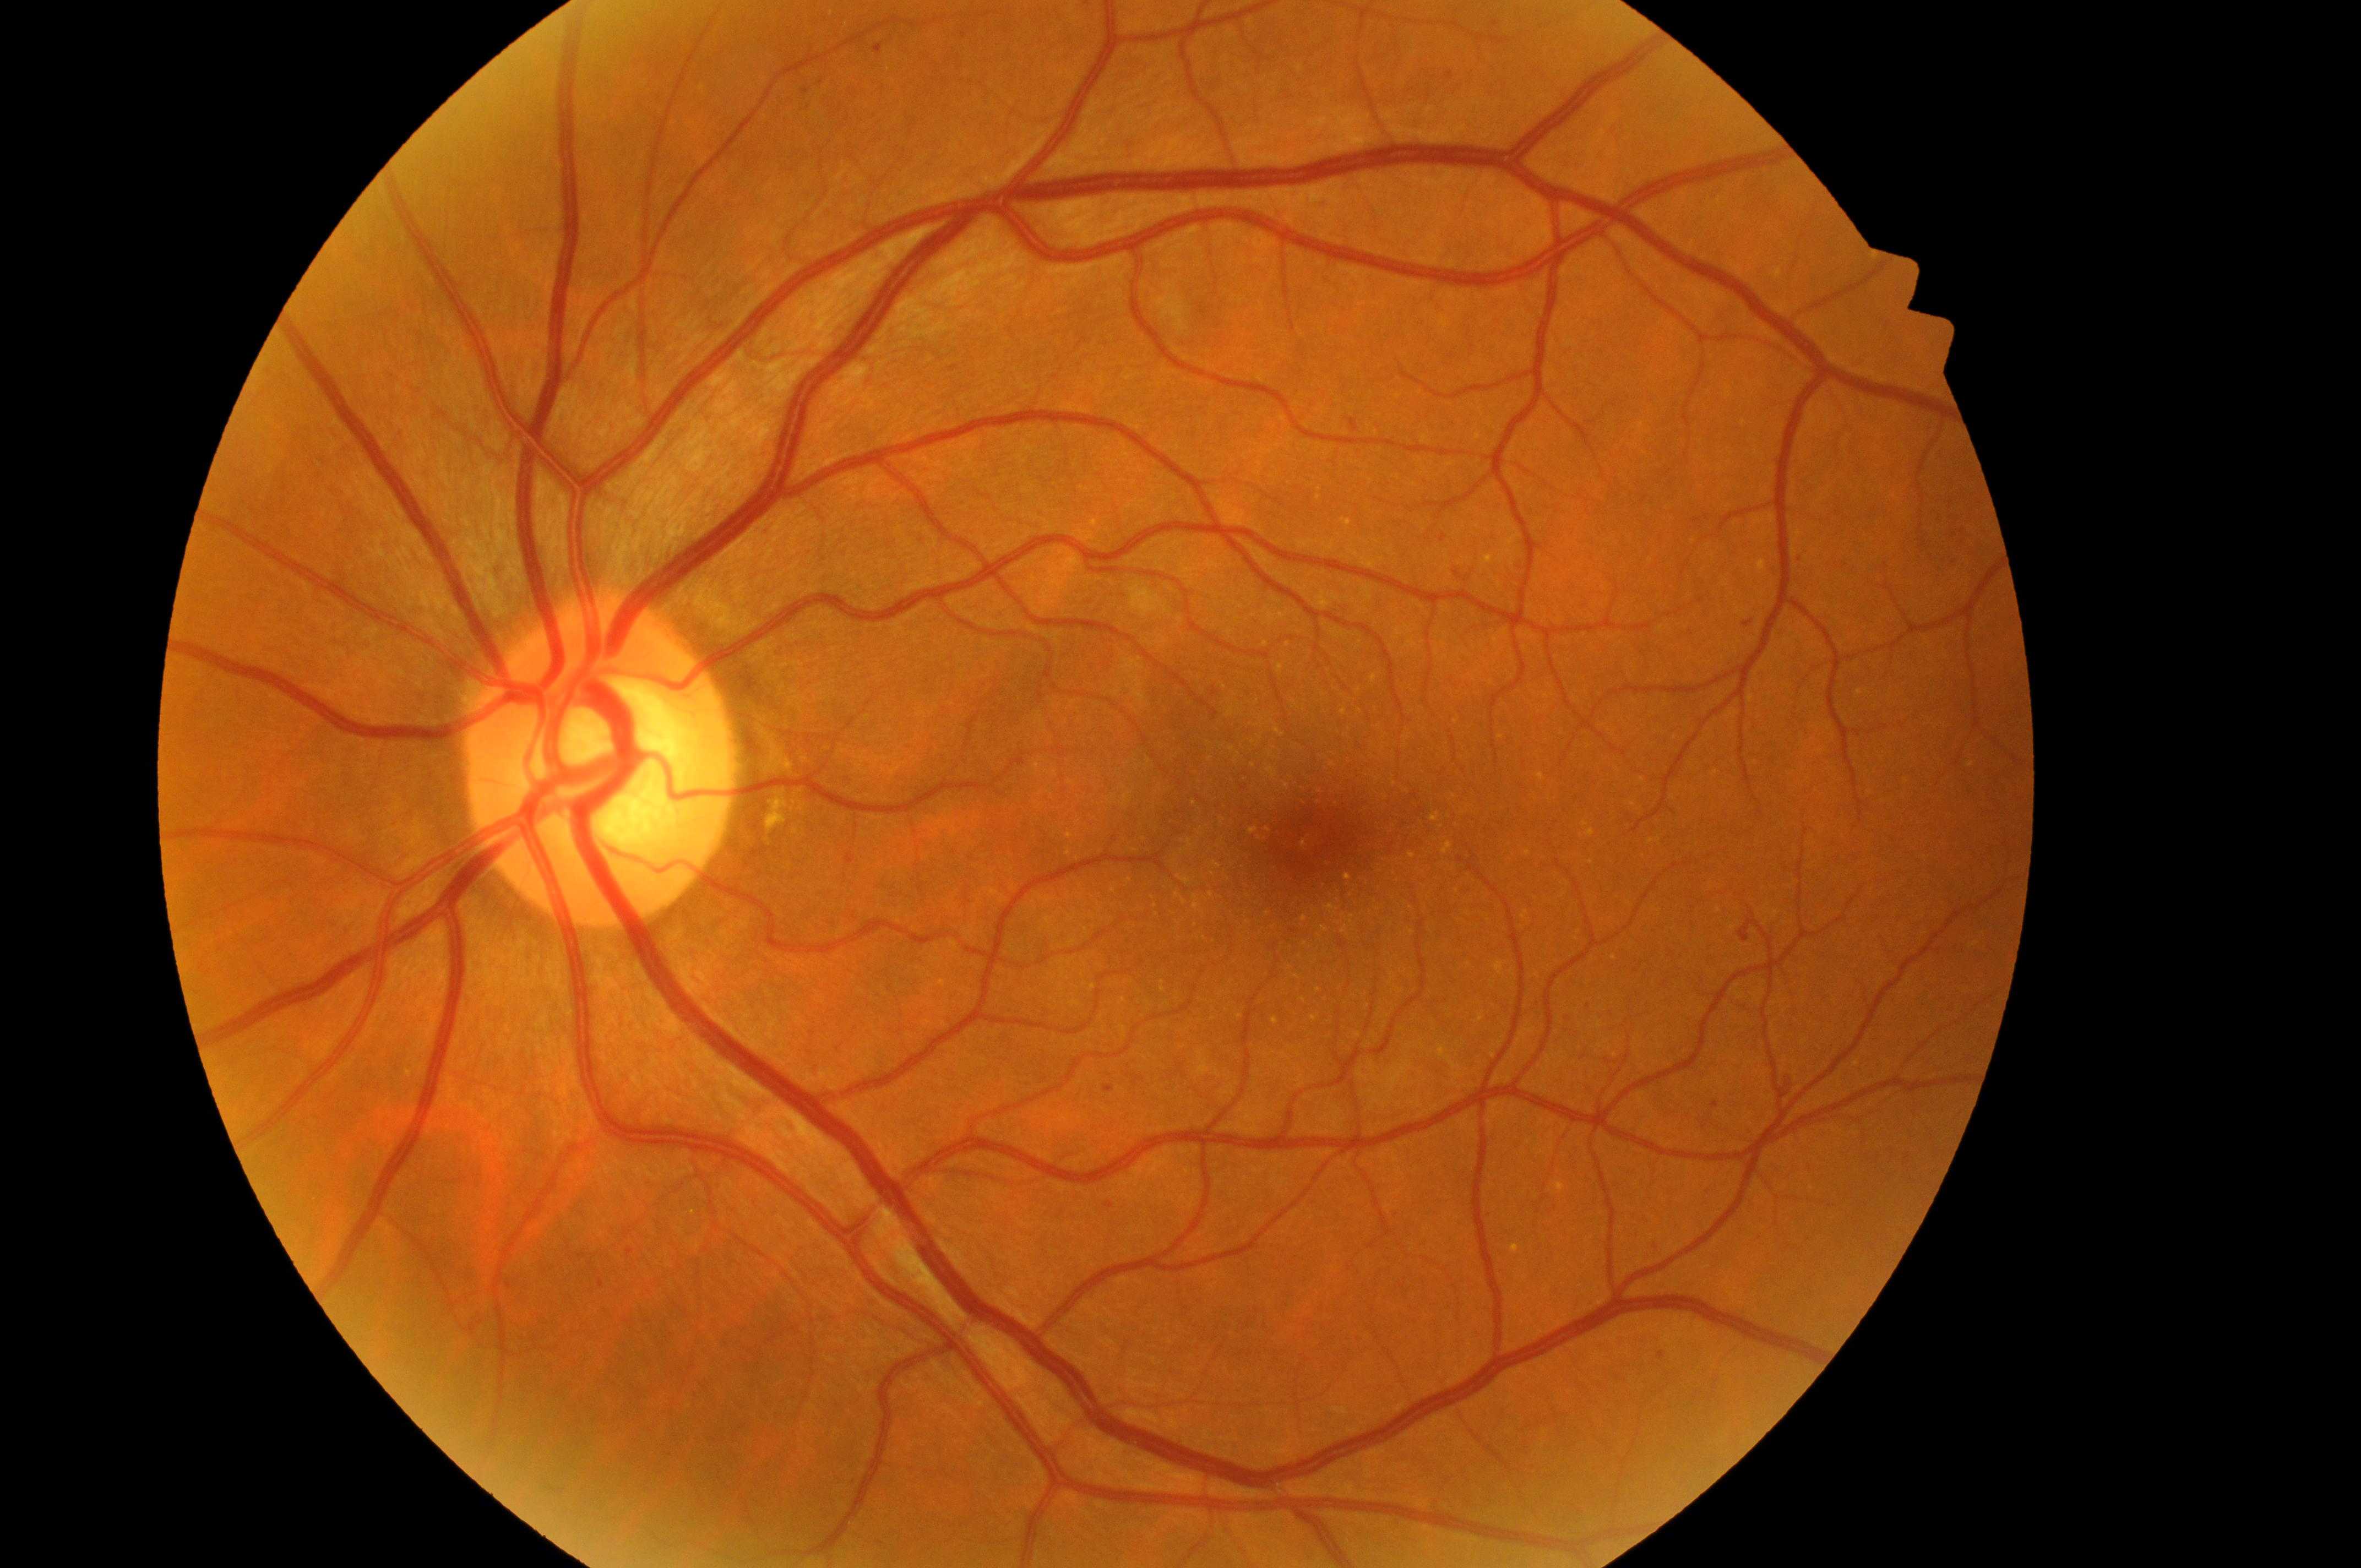 The image shows the OS. Fovea centralis: 1312px, 845px. Risk of diabetic macular edema is grade 1 (low risk). Retinopathy grade is moderate non-proliferative diabetic retinopathy (2). Optic disc center: 594px, 775px.